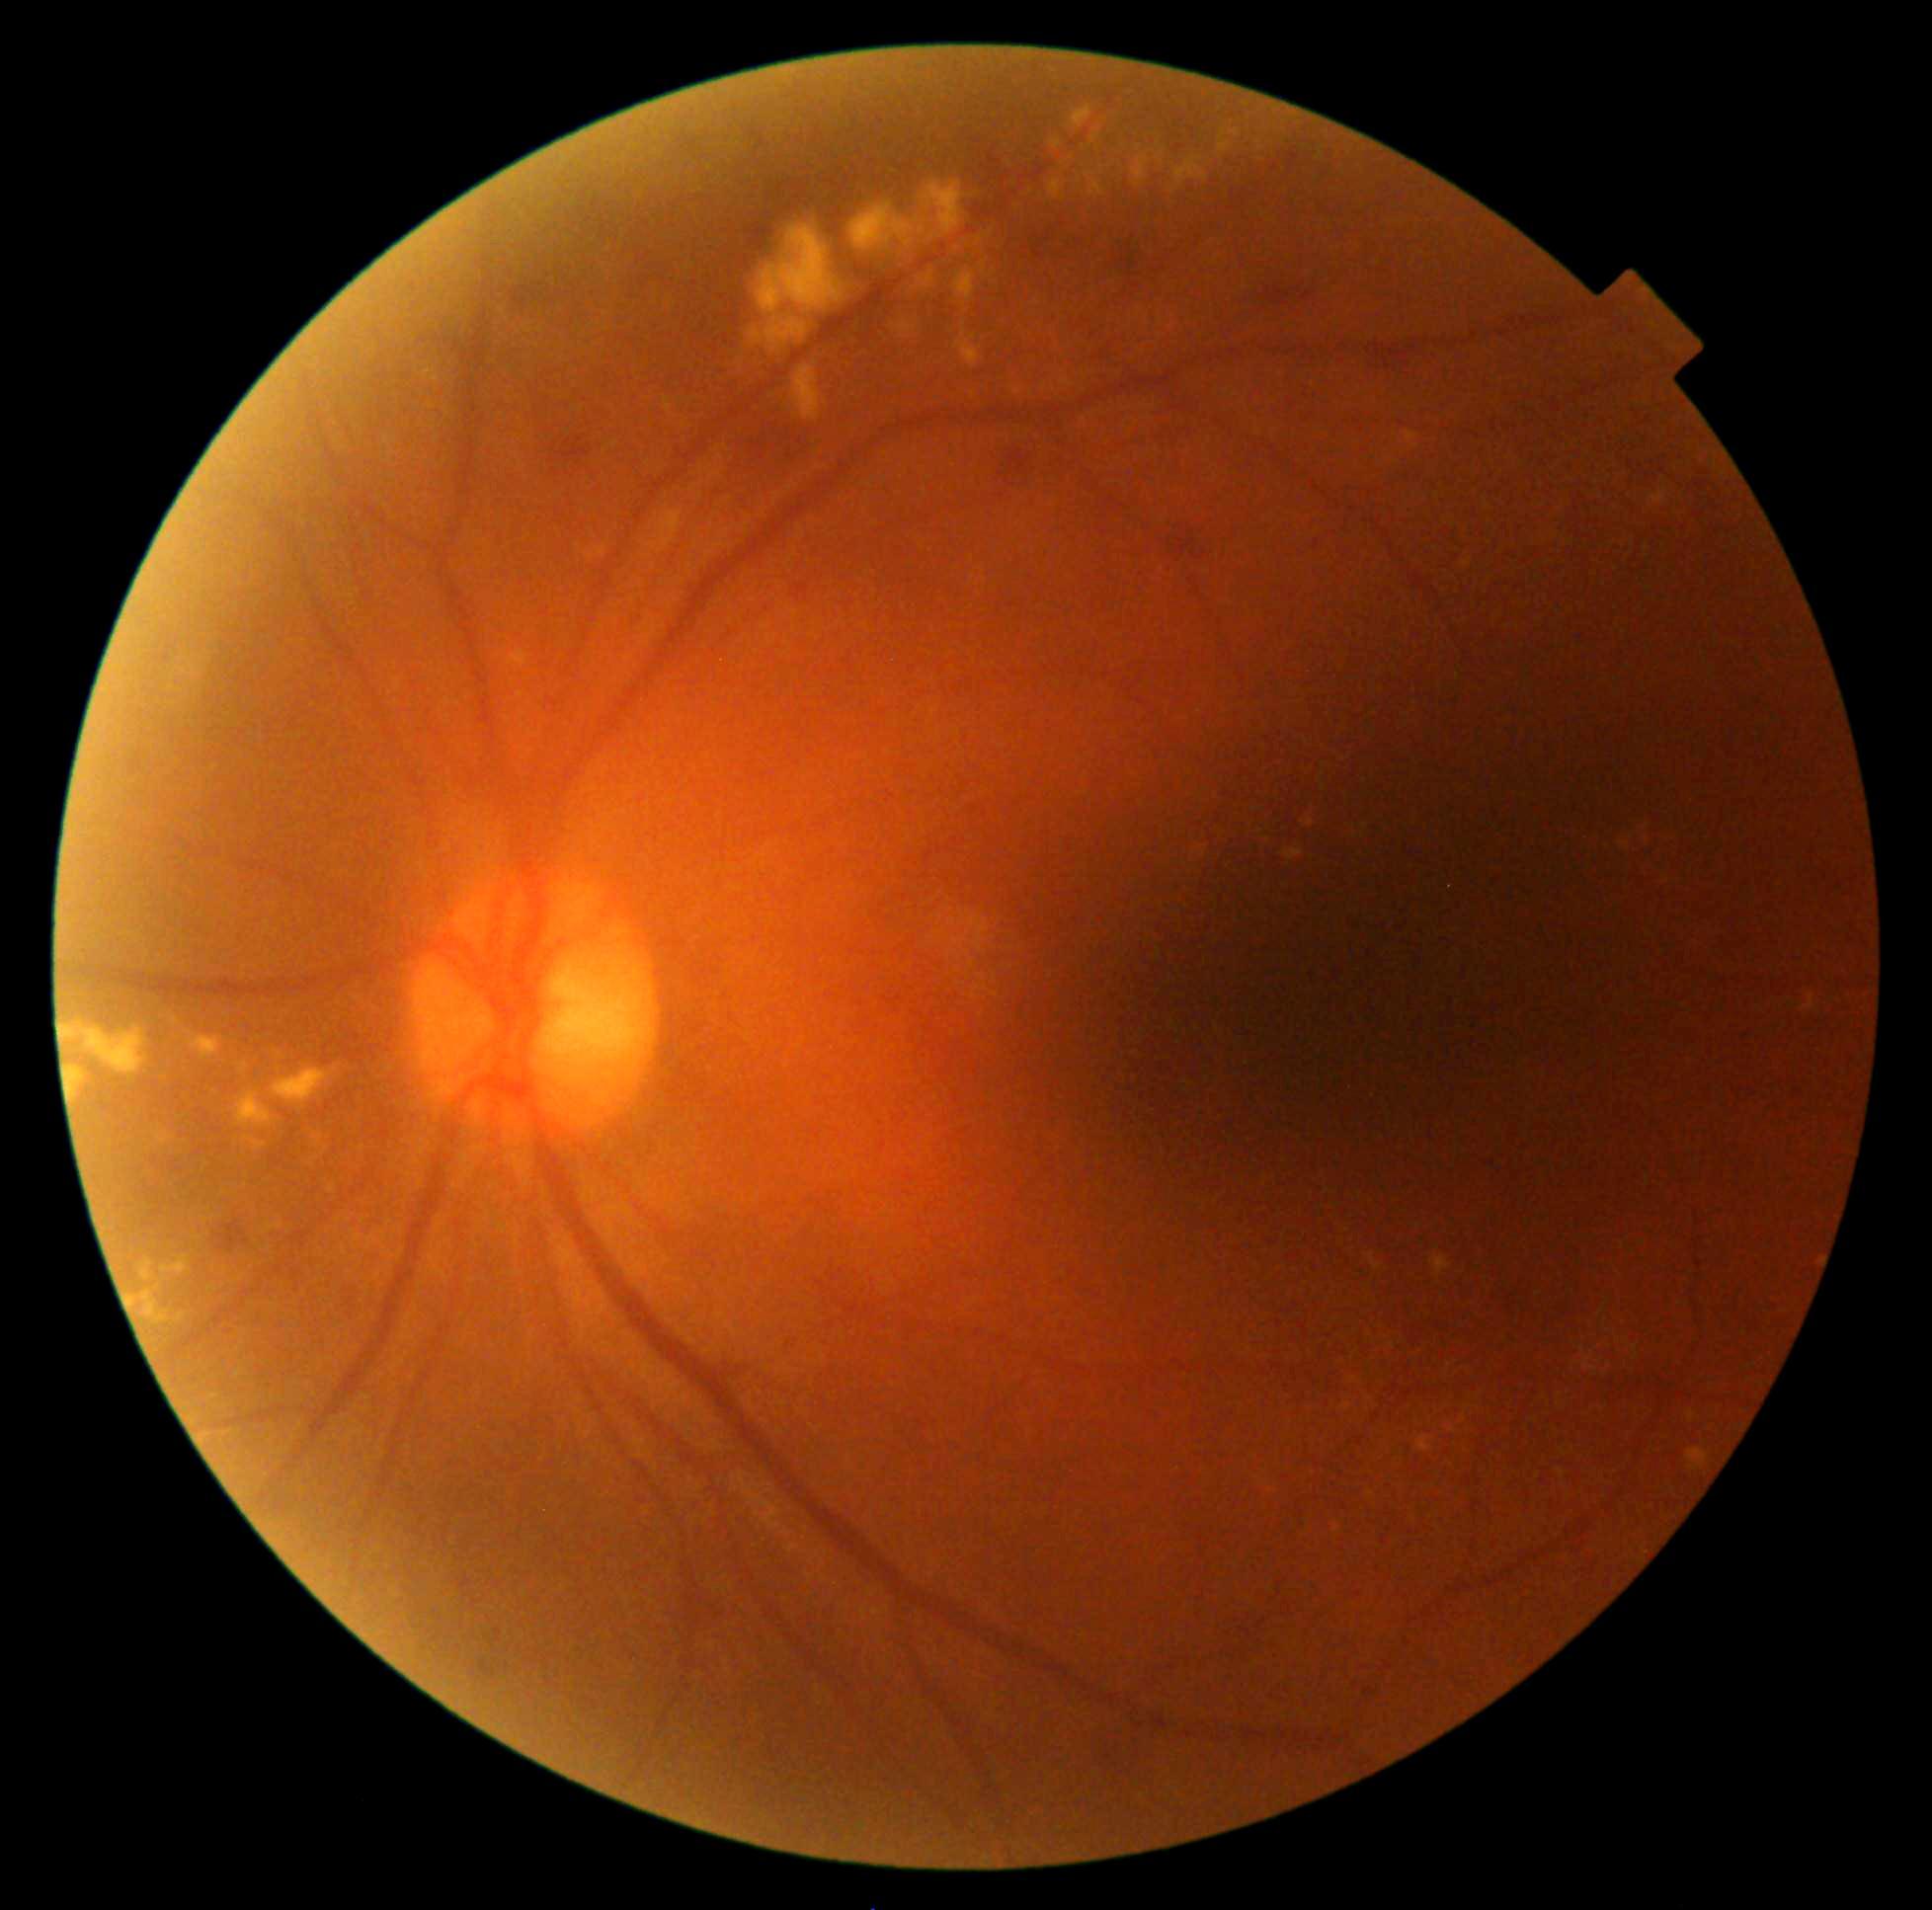

partial: true
dr_grade: 2
dr_grade_name: moderate NPDR
lesions:
  ma: []
  se: []
  ex:
    - [67,1067,86,1100]
    - [757,225,844,353]
    - [1431,1255,1451,1277]
    - [234,1091,274,1127]
    - [585,552,594,559]
    - [1307,819,1316,828]
    - [1449,1427,1457,1432]
    - [265,1224,282,1234]
    - [1367,1254,1382,1270]
    - [1051,140,1062,151]
    - [1219,130,1232,152]
    - [272,1067,338,1109]
    - [176,1313,187,1321]
    - [1013,390,1022,395]
    - [1687,1449,1710,1472]
  ex_small:
    - {"x": 1648, "y": 548}
    - {"x": 158, "y": 1288}
    - {"x": 1416, "y": 446}
    - {"x": 1325, "y": 788}
  he:
    - [501,265,565,315]
    - [1289,147,1301,174]
    - [1192,554,1206,561]
    - [213,1220,249,1254]
    - [1272,154,1283,174]
    - [678,134,699,152]
    - [558,438,592,461]
    - [739,411,808,477]
  he_small:
    - {"x": 556, "y": 473}
    - {"x": 552, "y": 461}
    - {"x": 568, "y": 475}